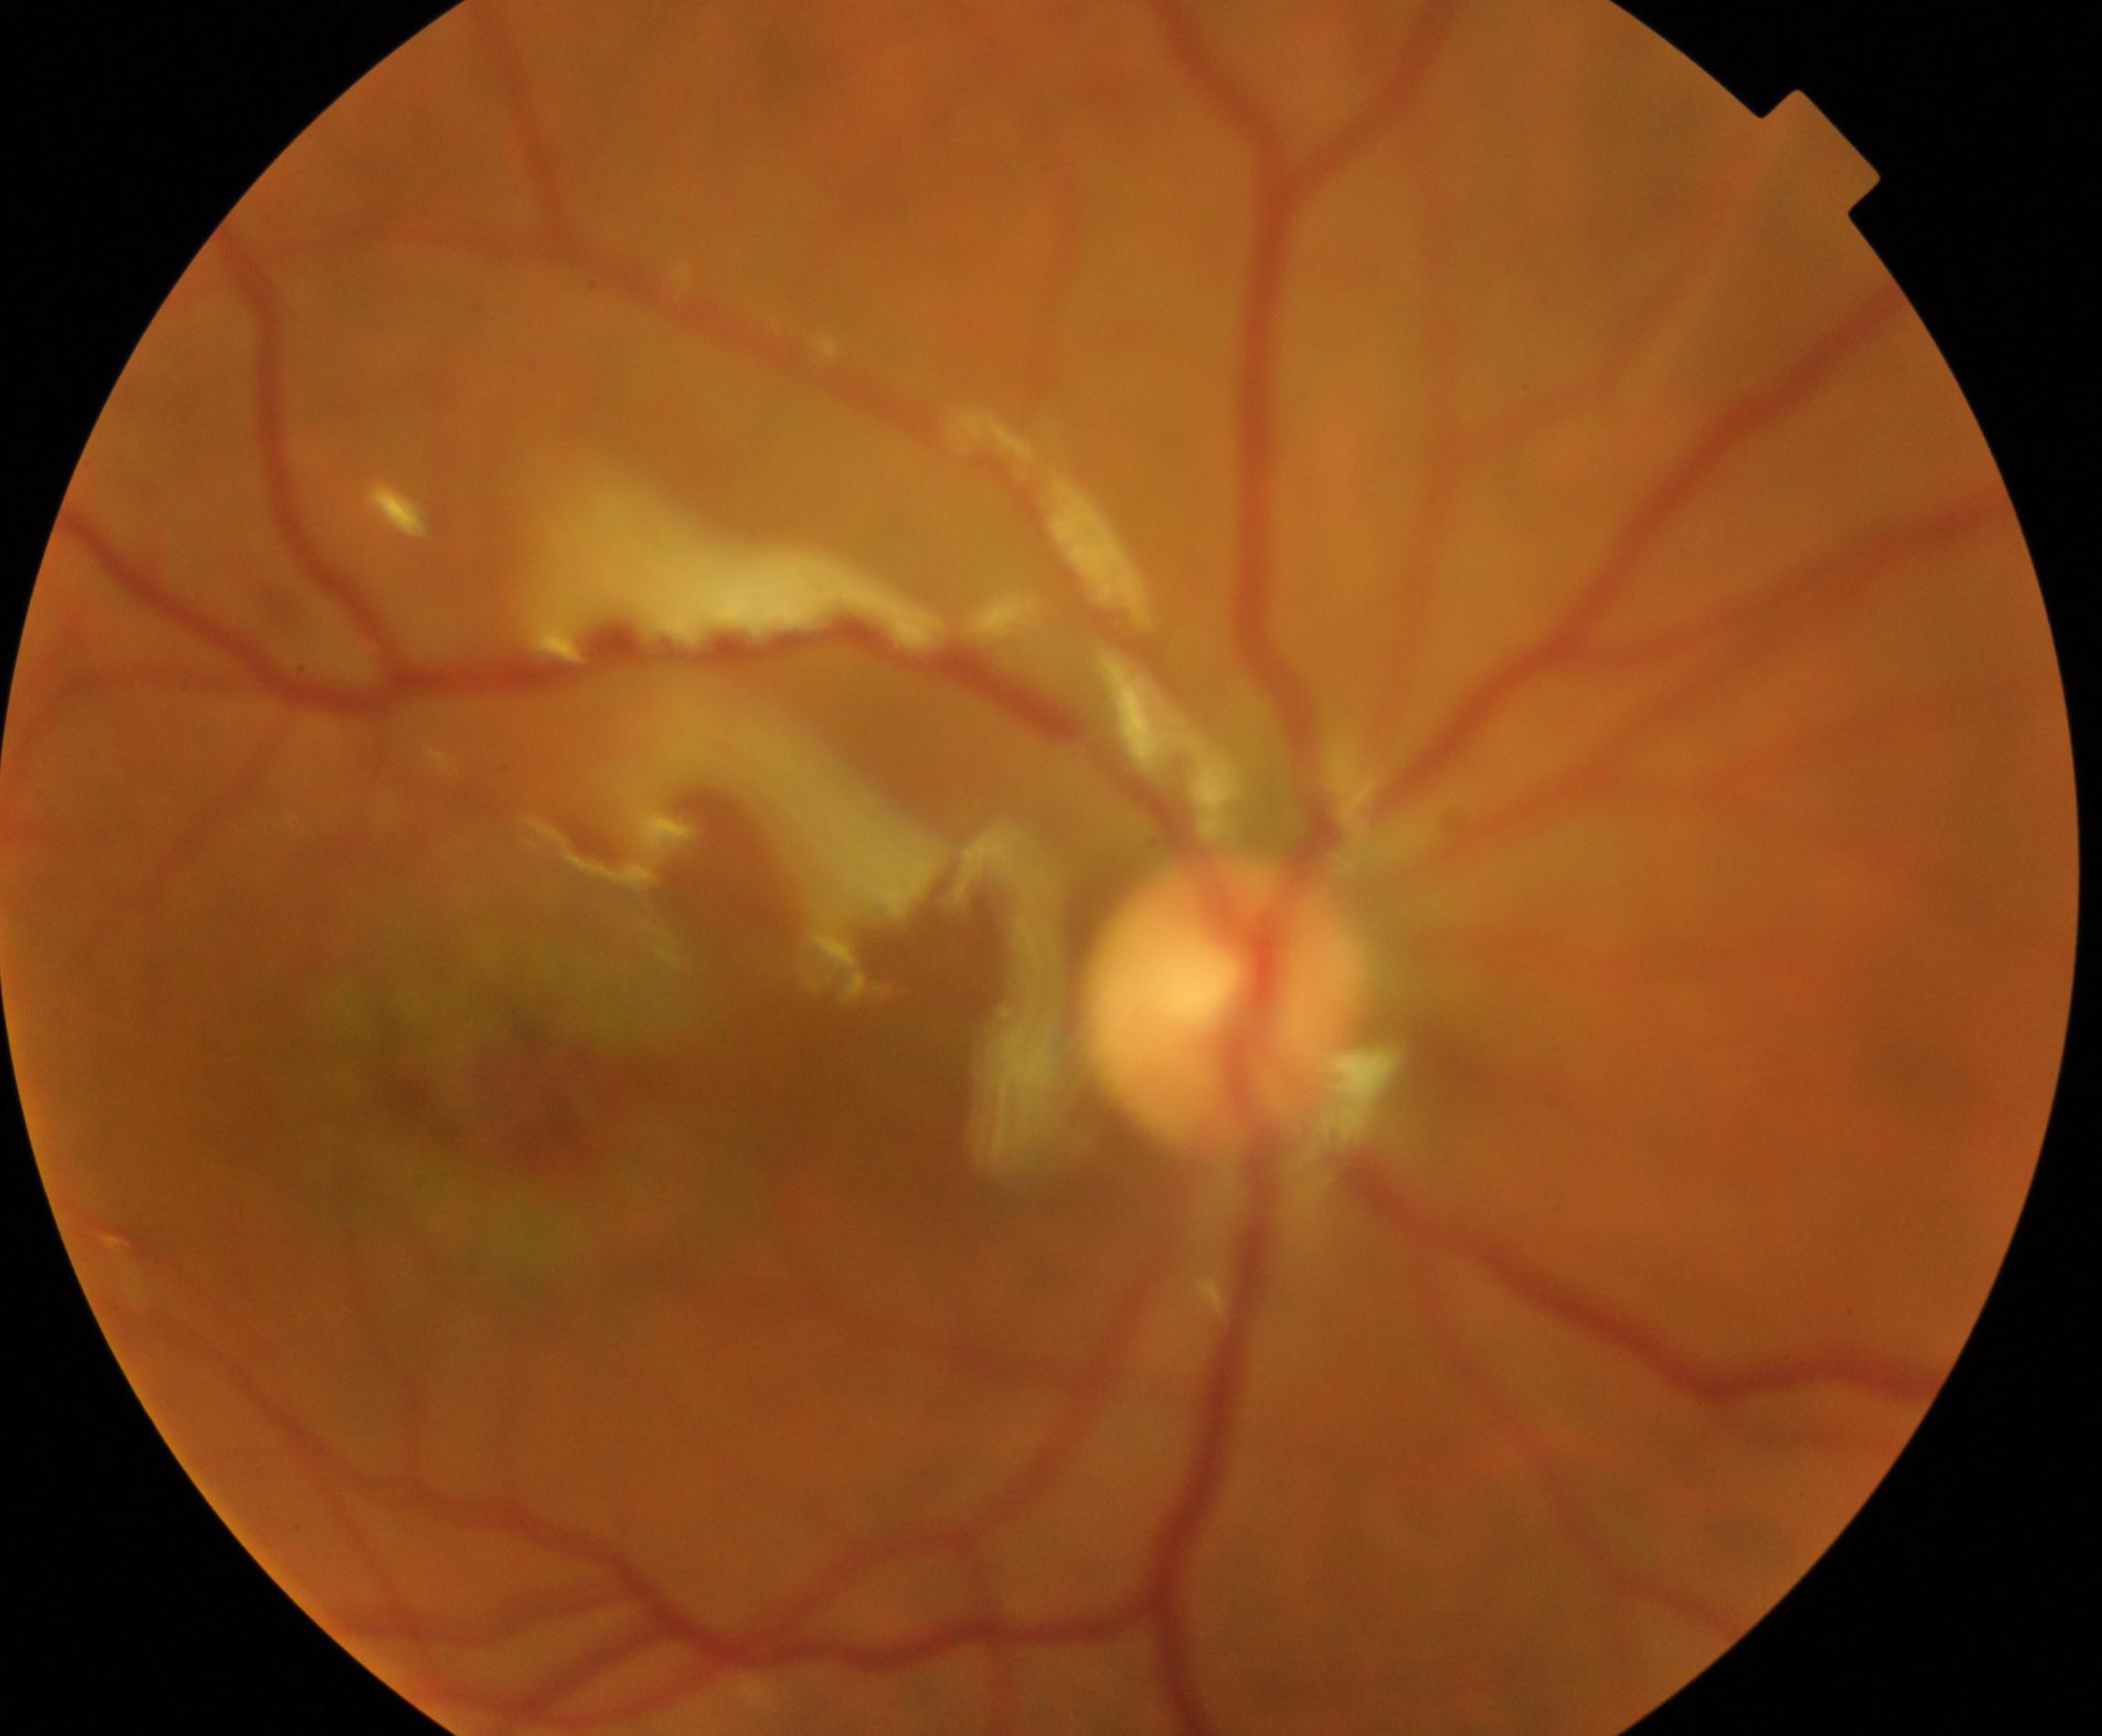

Impression: silicone oil in the eye.